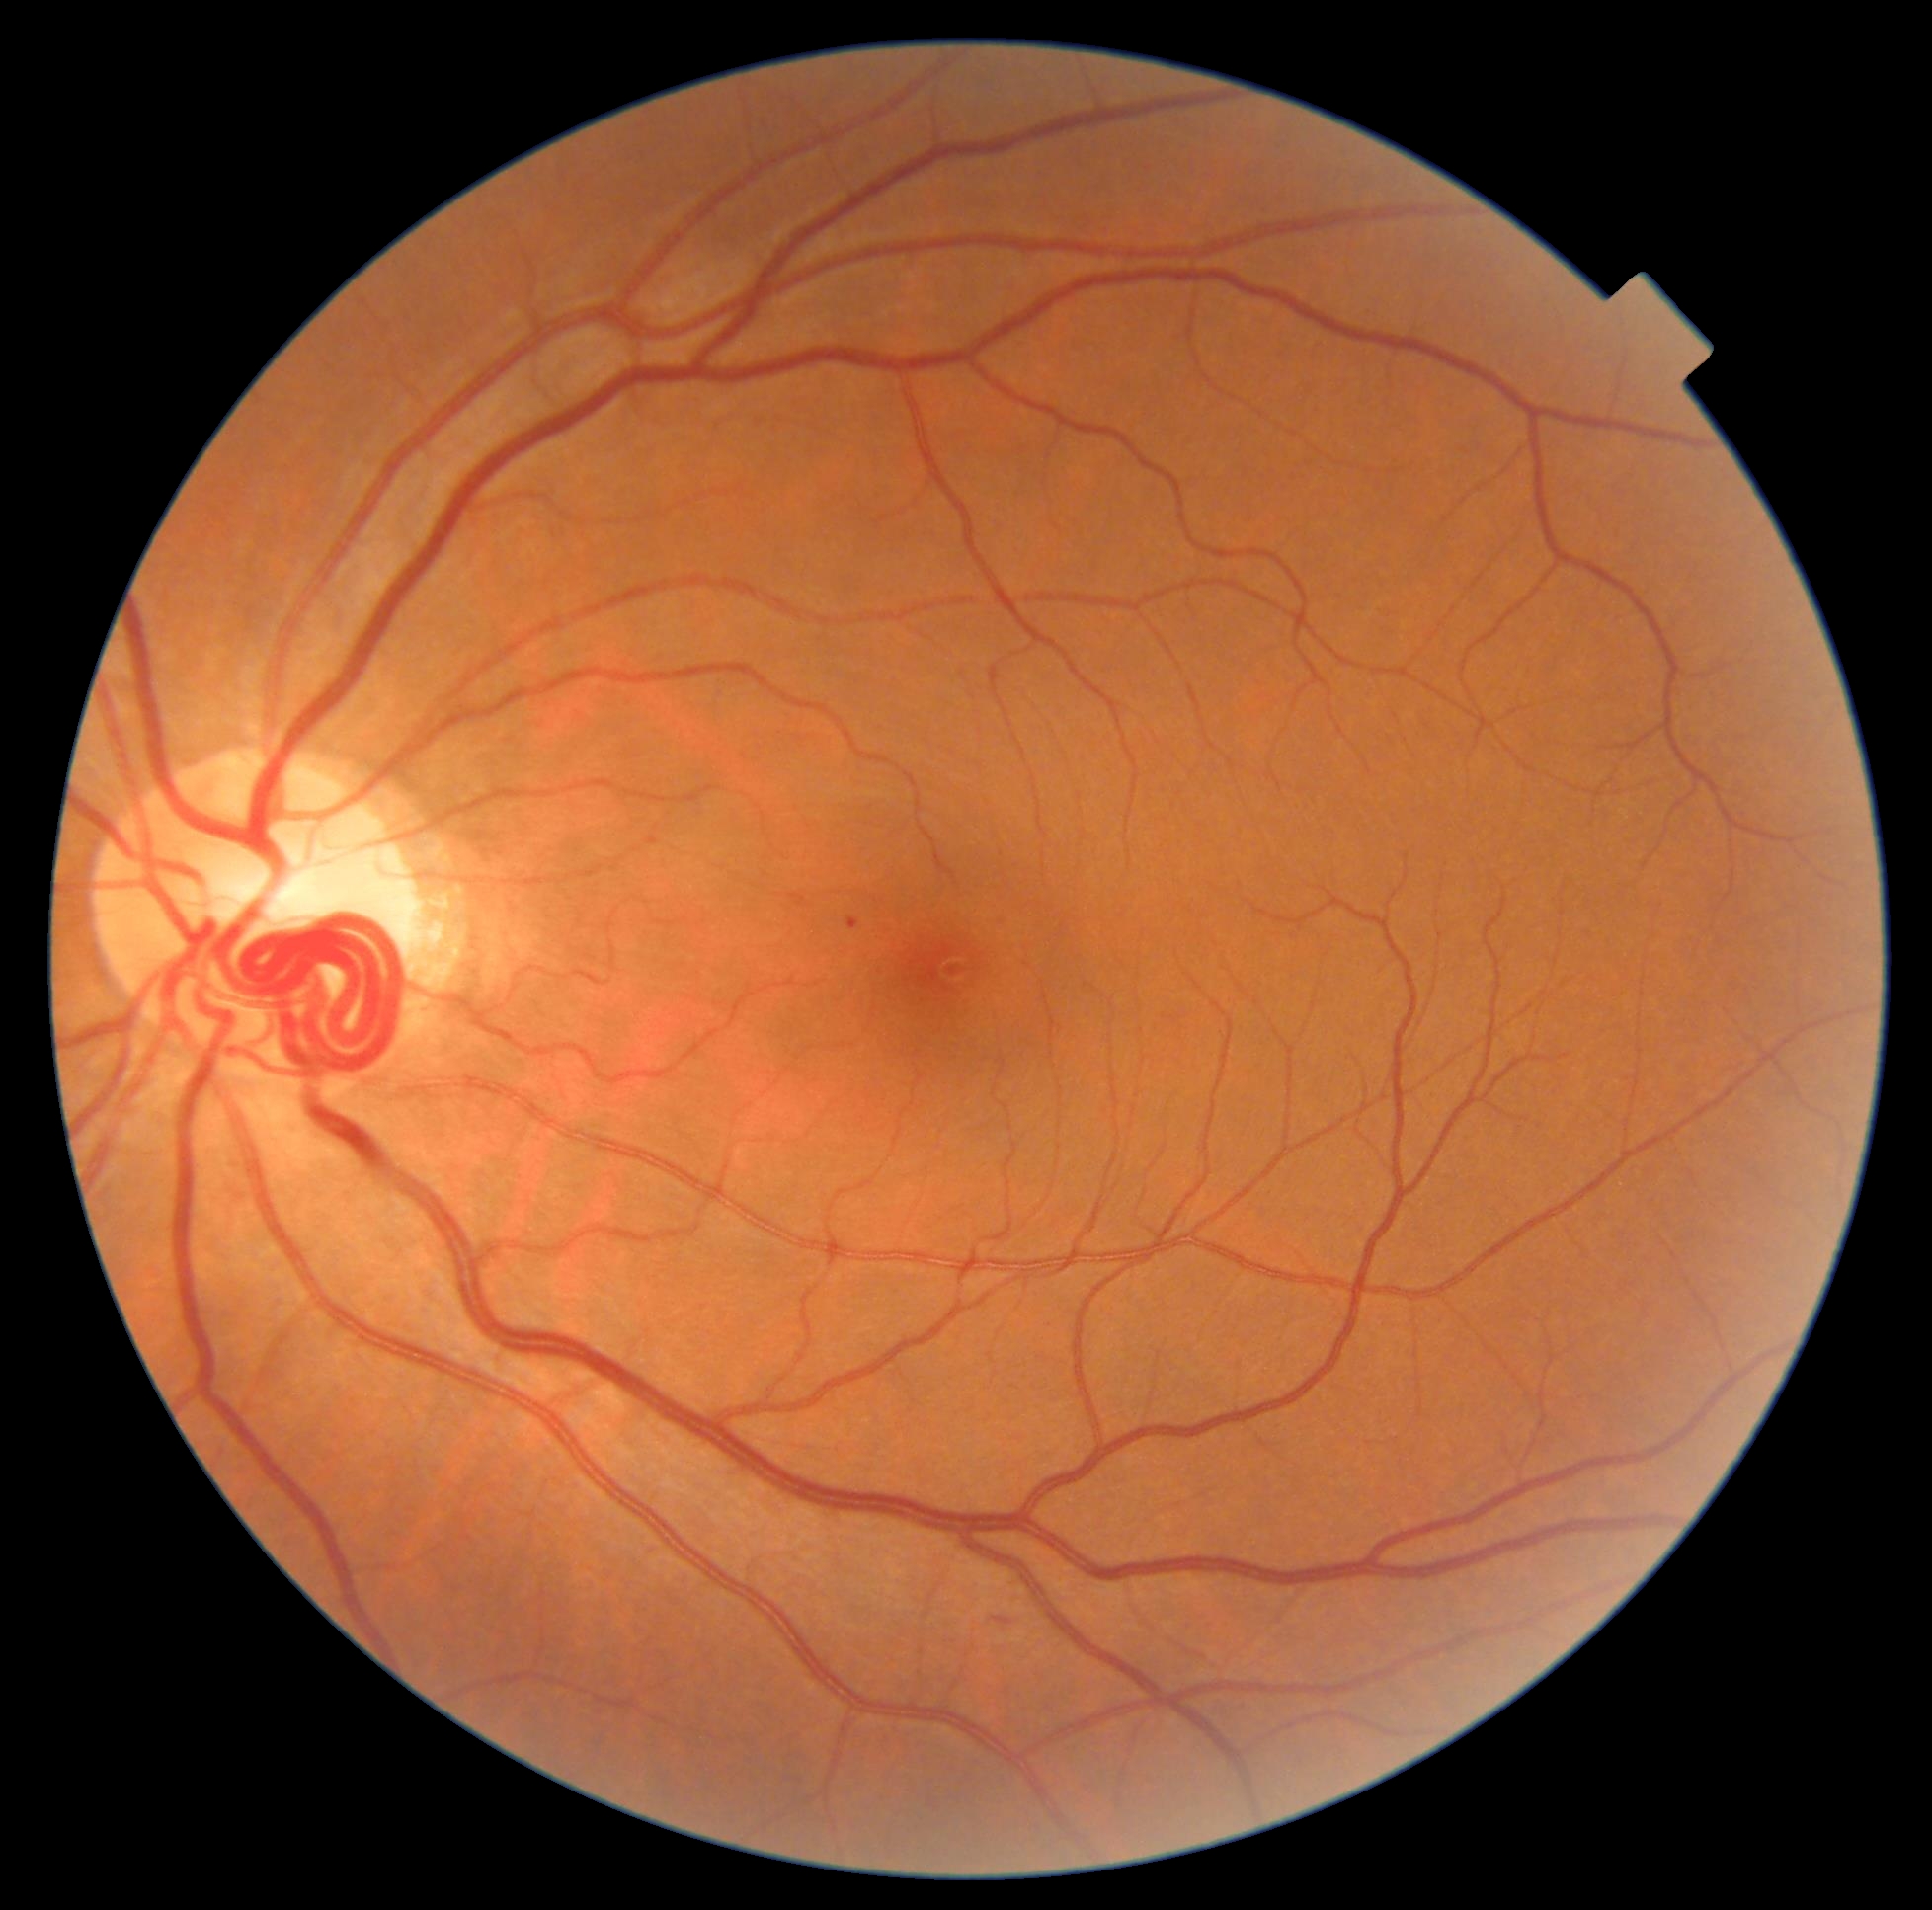 • retinopathy — grade 2 (moderate NPDR)